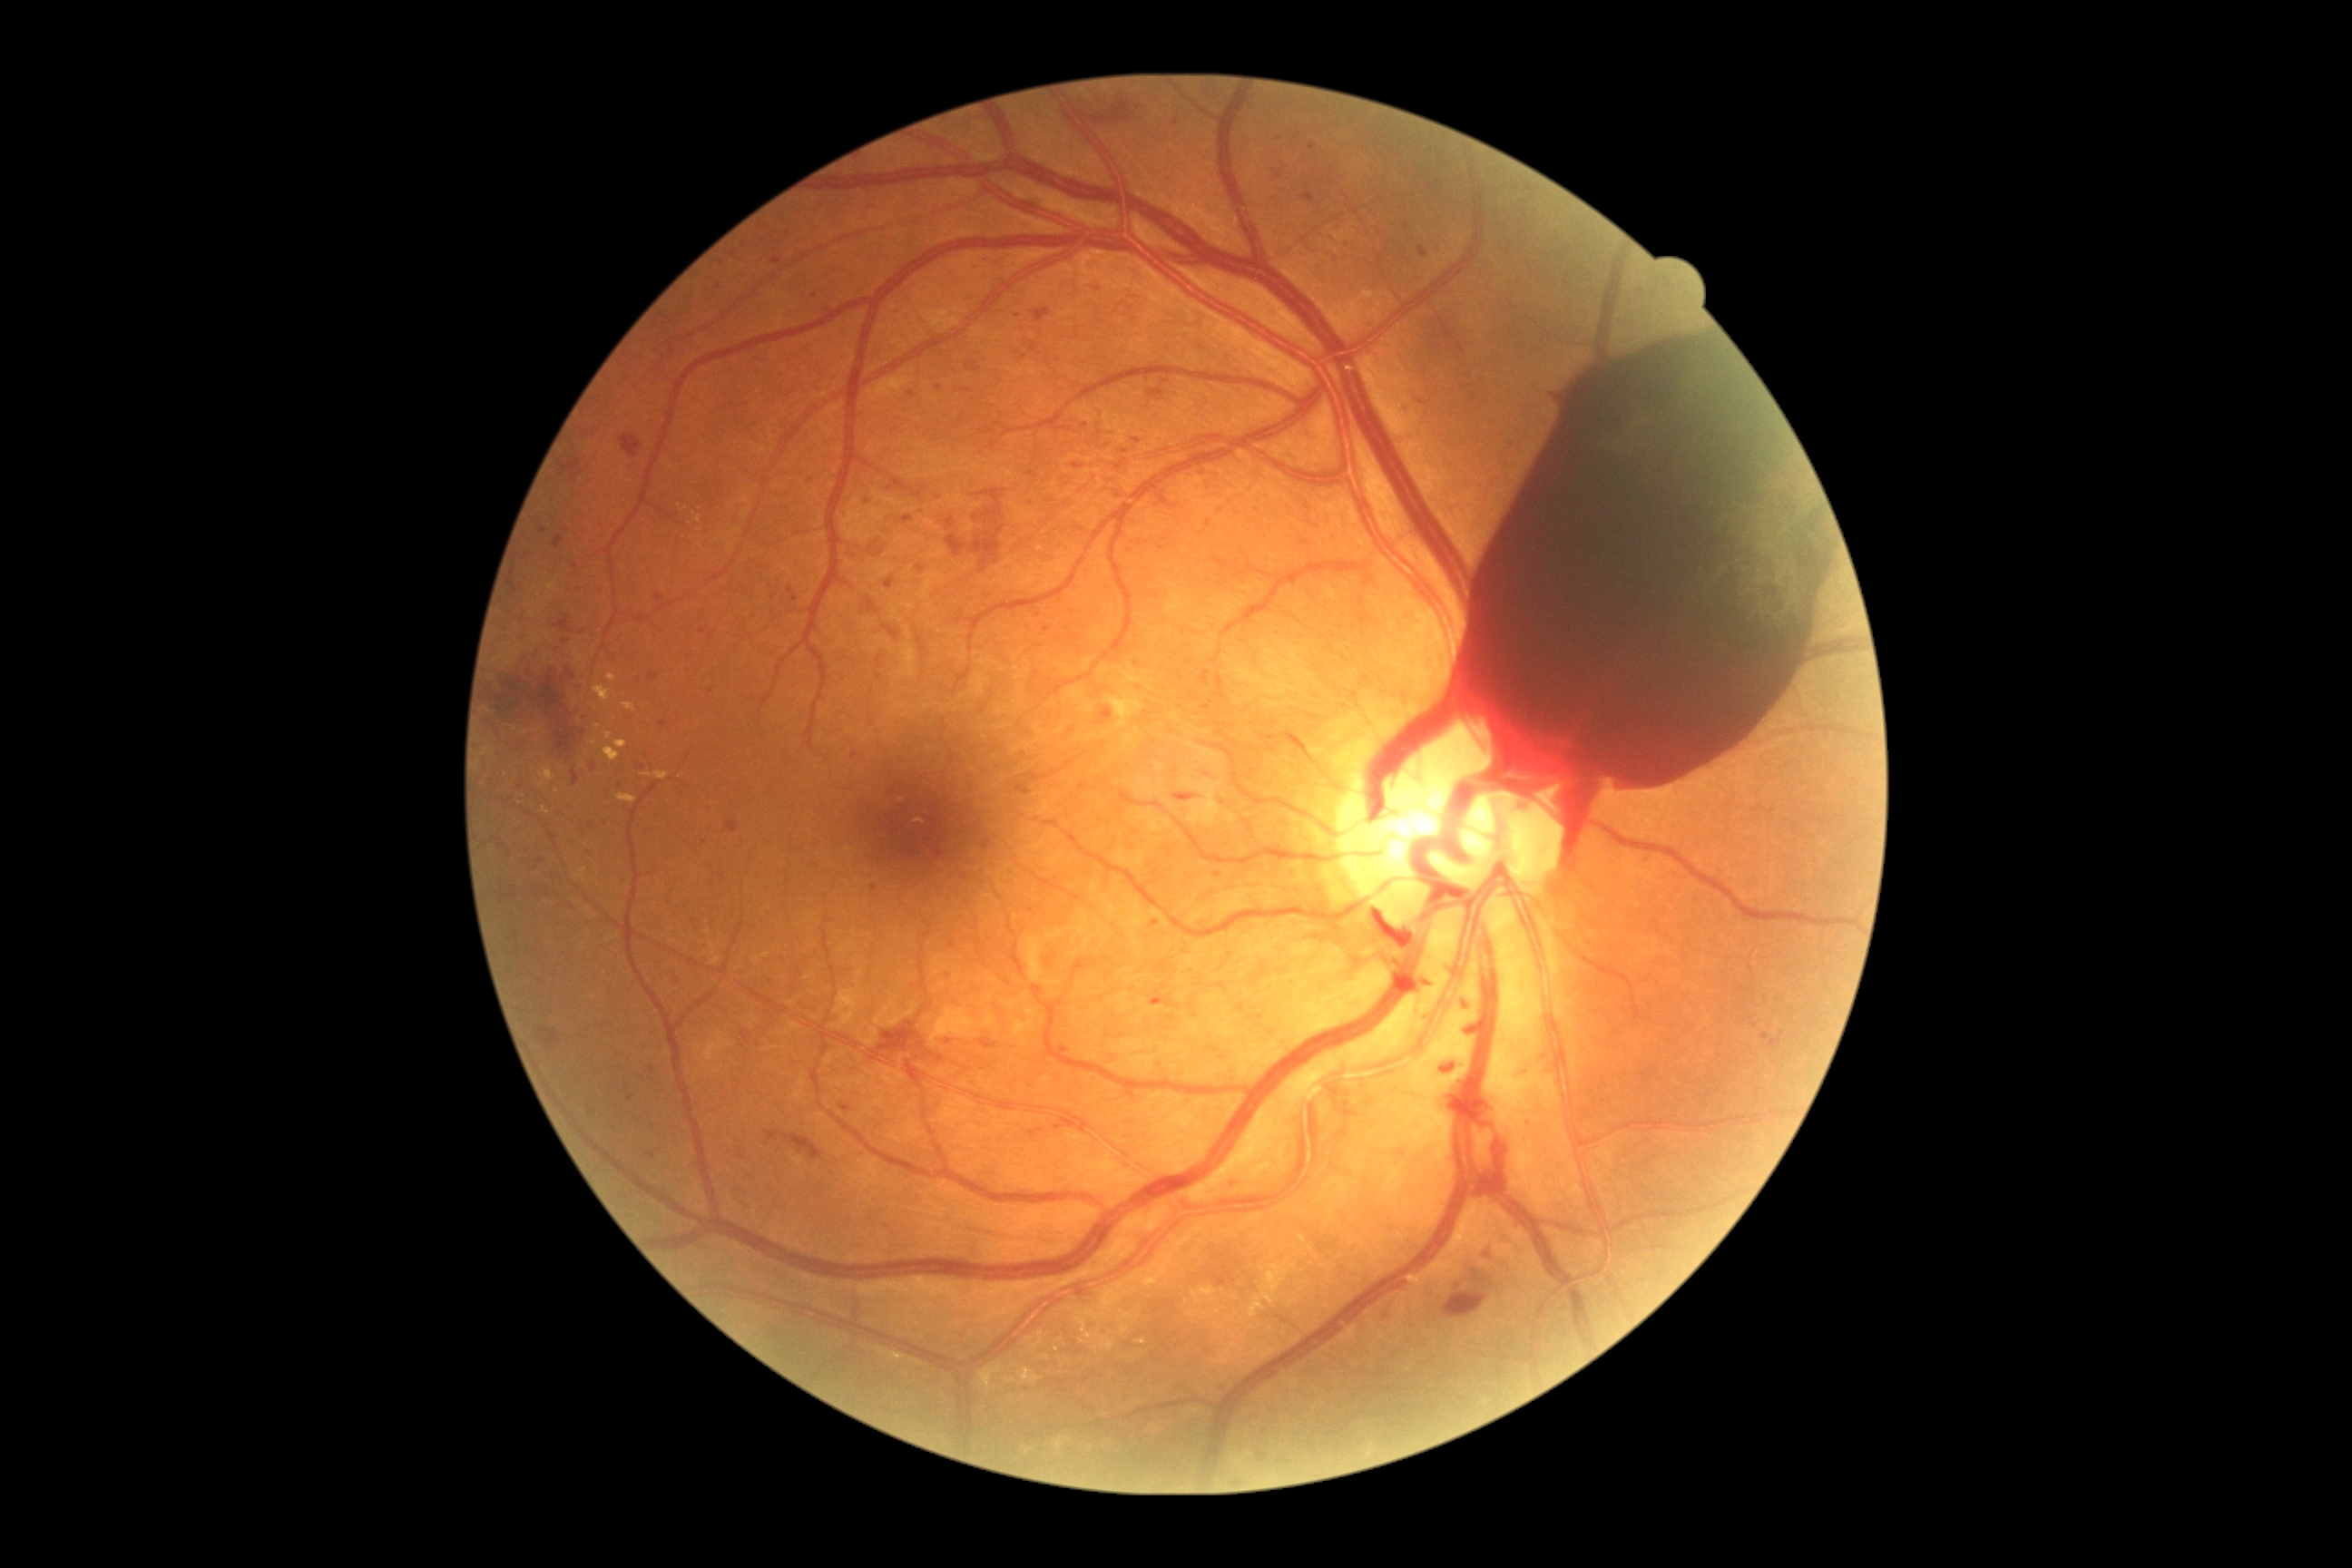 DR stage: 4/4.